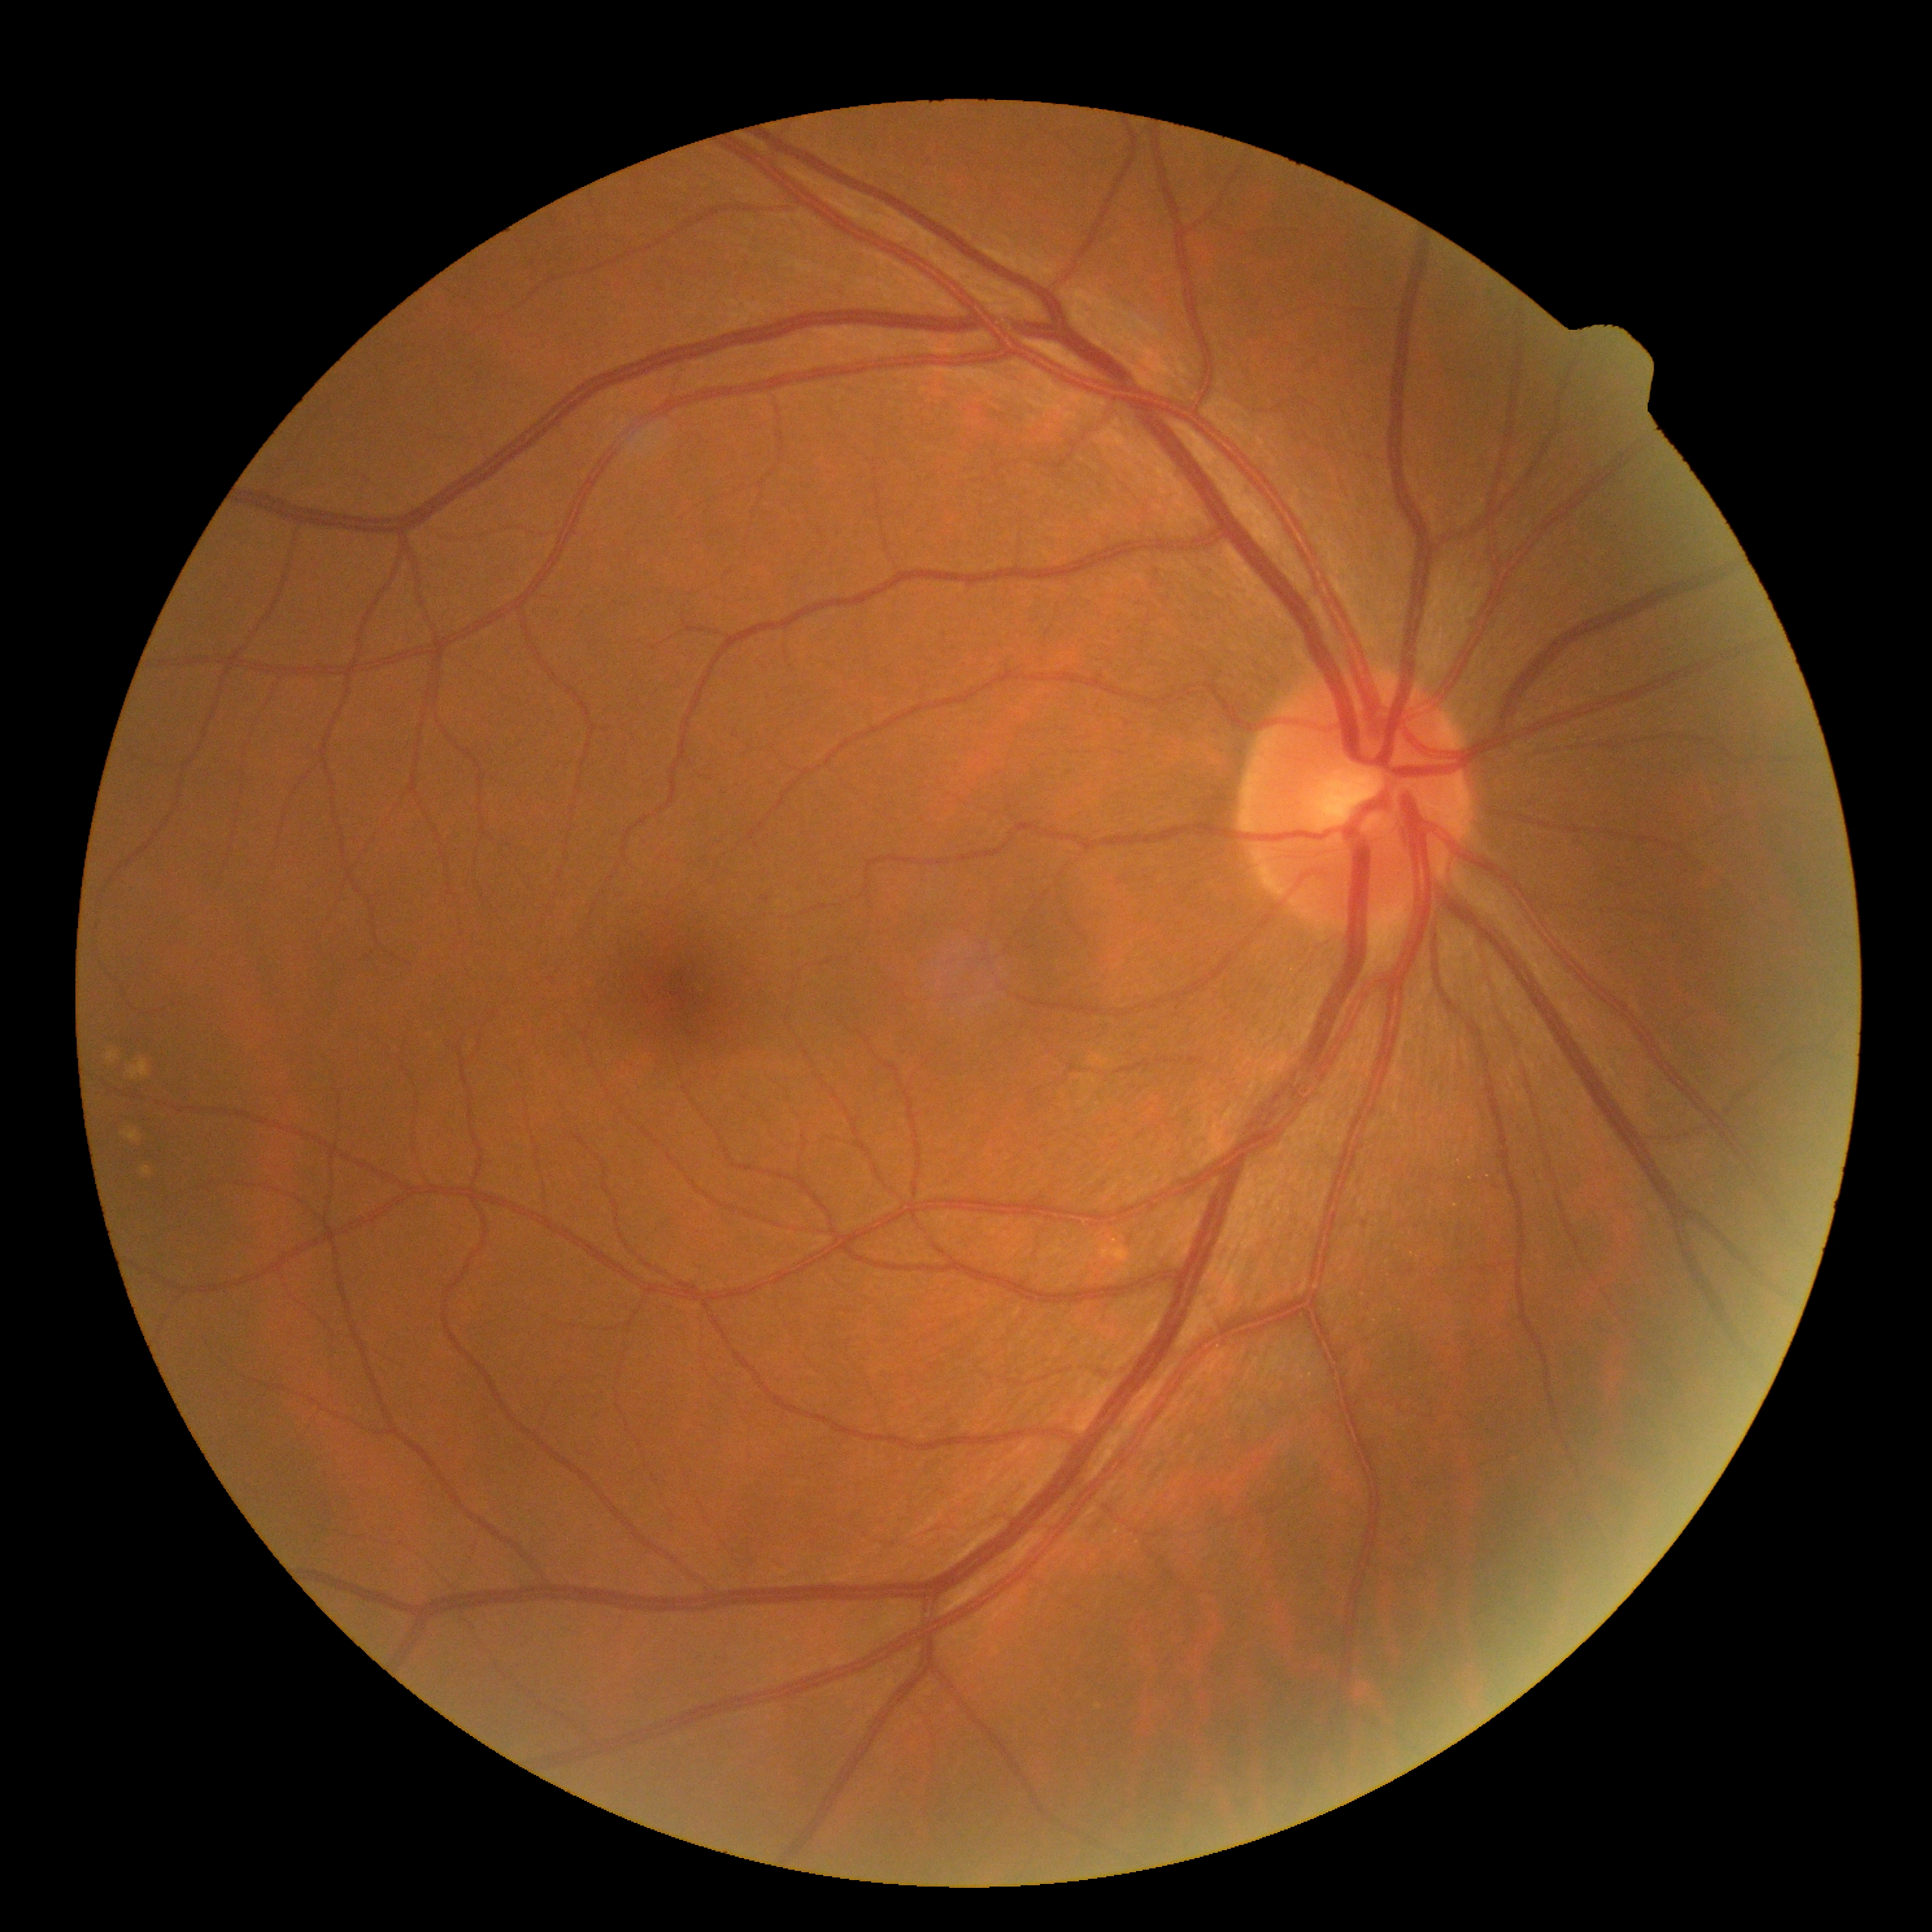 DR is 0.